Infant wide-field retinal image
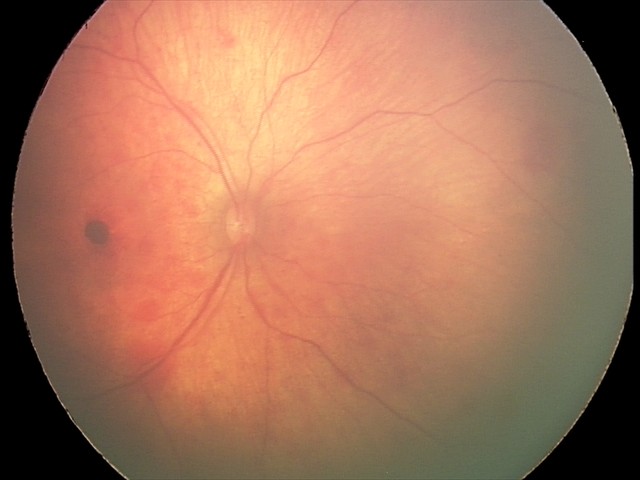 Assessment: retinal hemorrhages